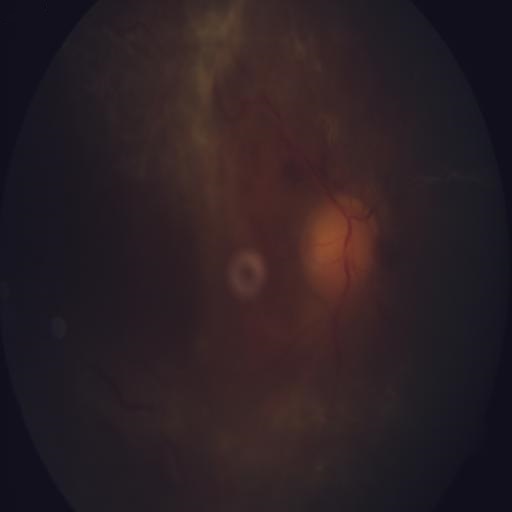
There is evidence of media haze.